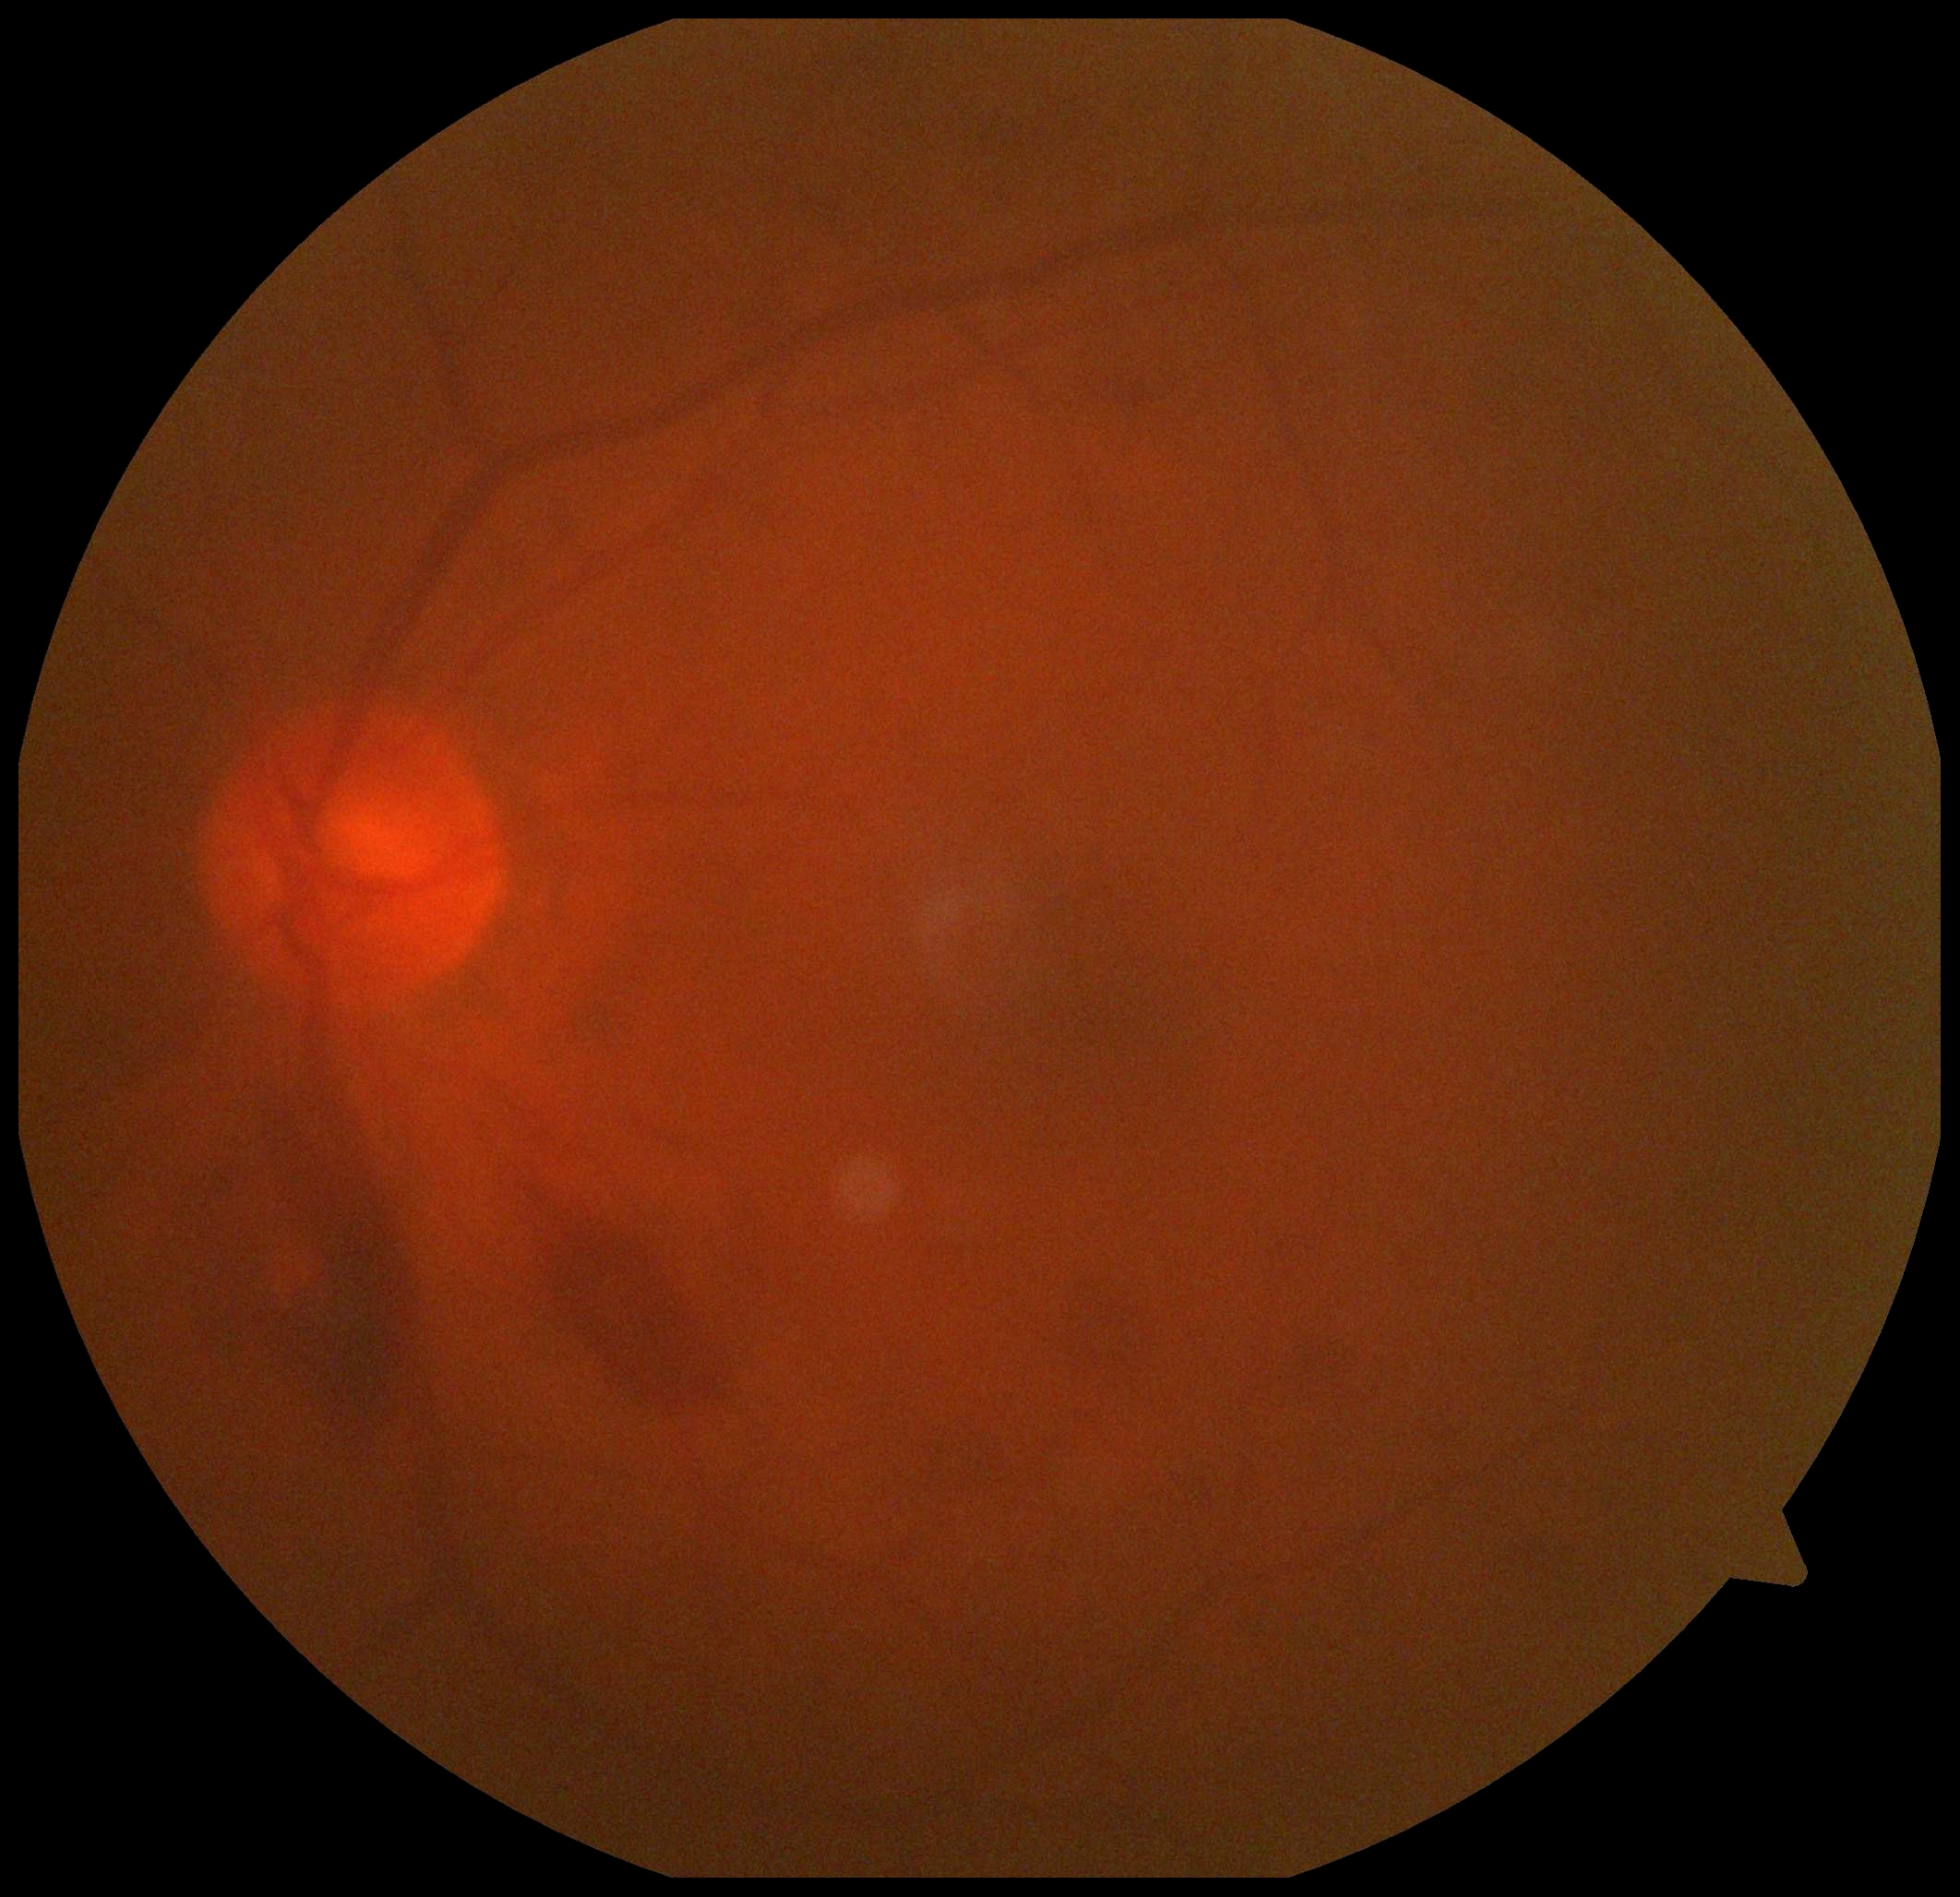
DR stage is grade 4 (PDR).